Fundus photo:
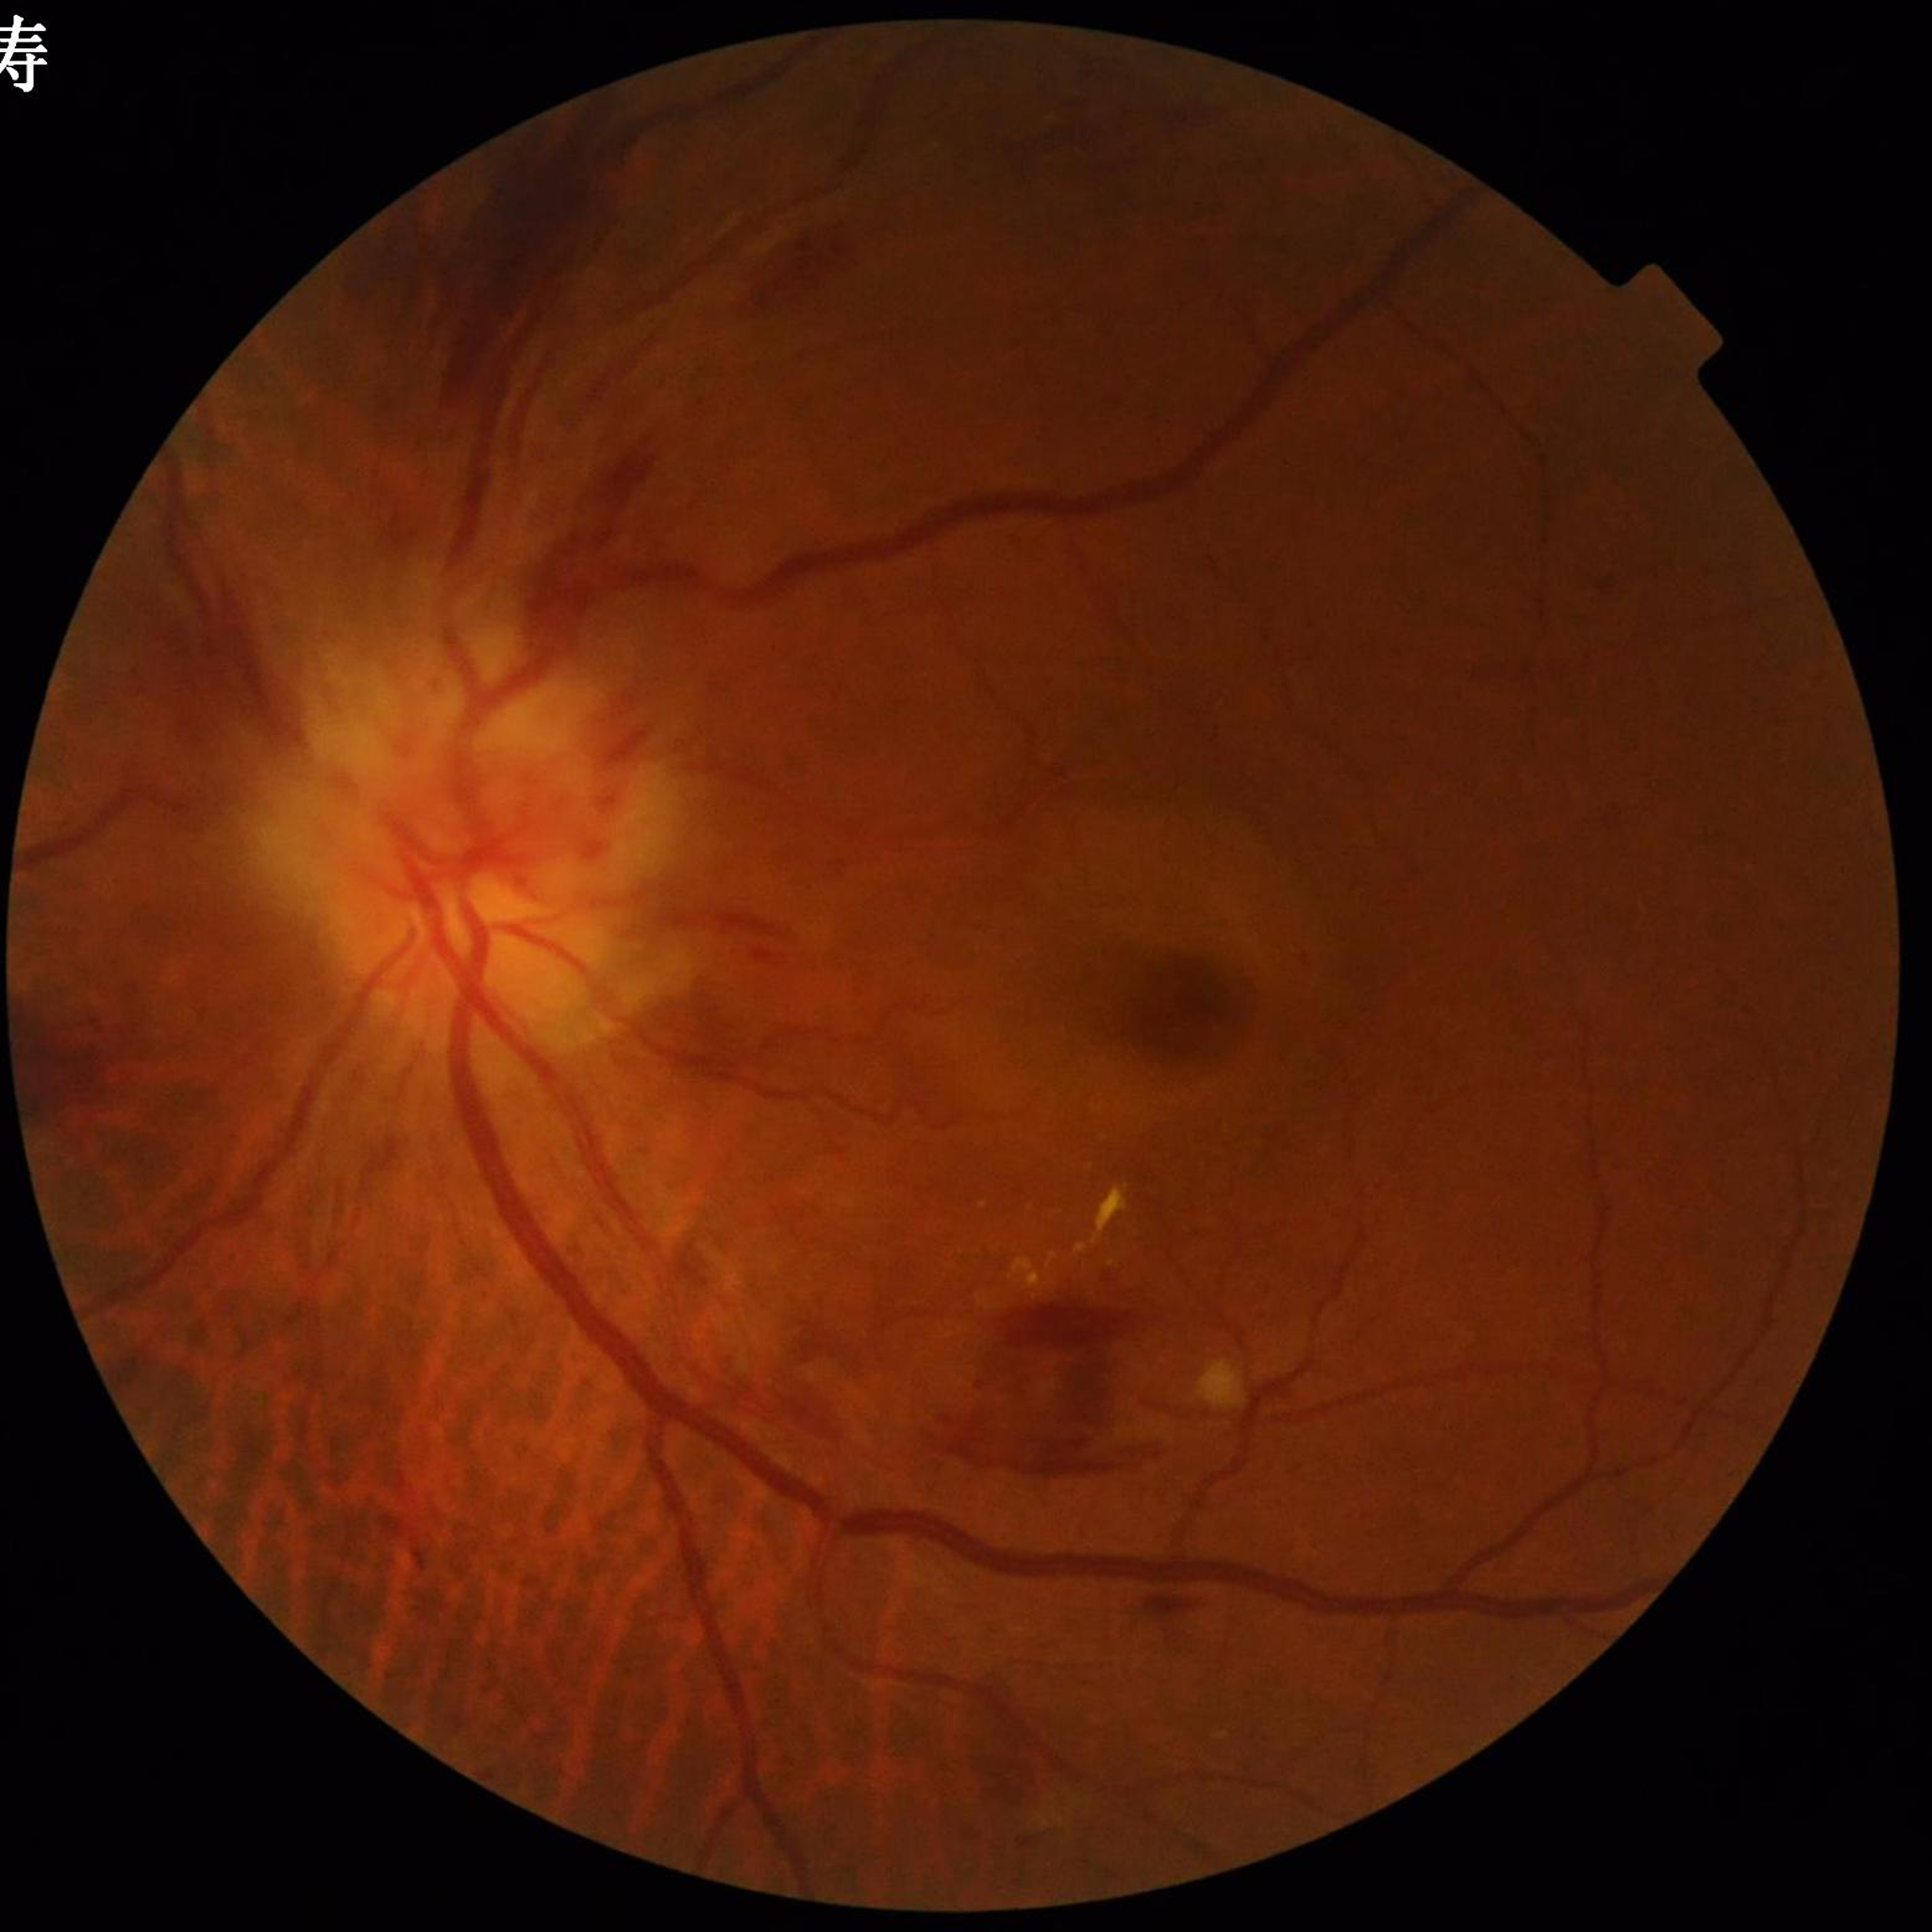 Quality: no concerns identified. From a patient with diabetic retinopathy.